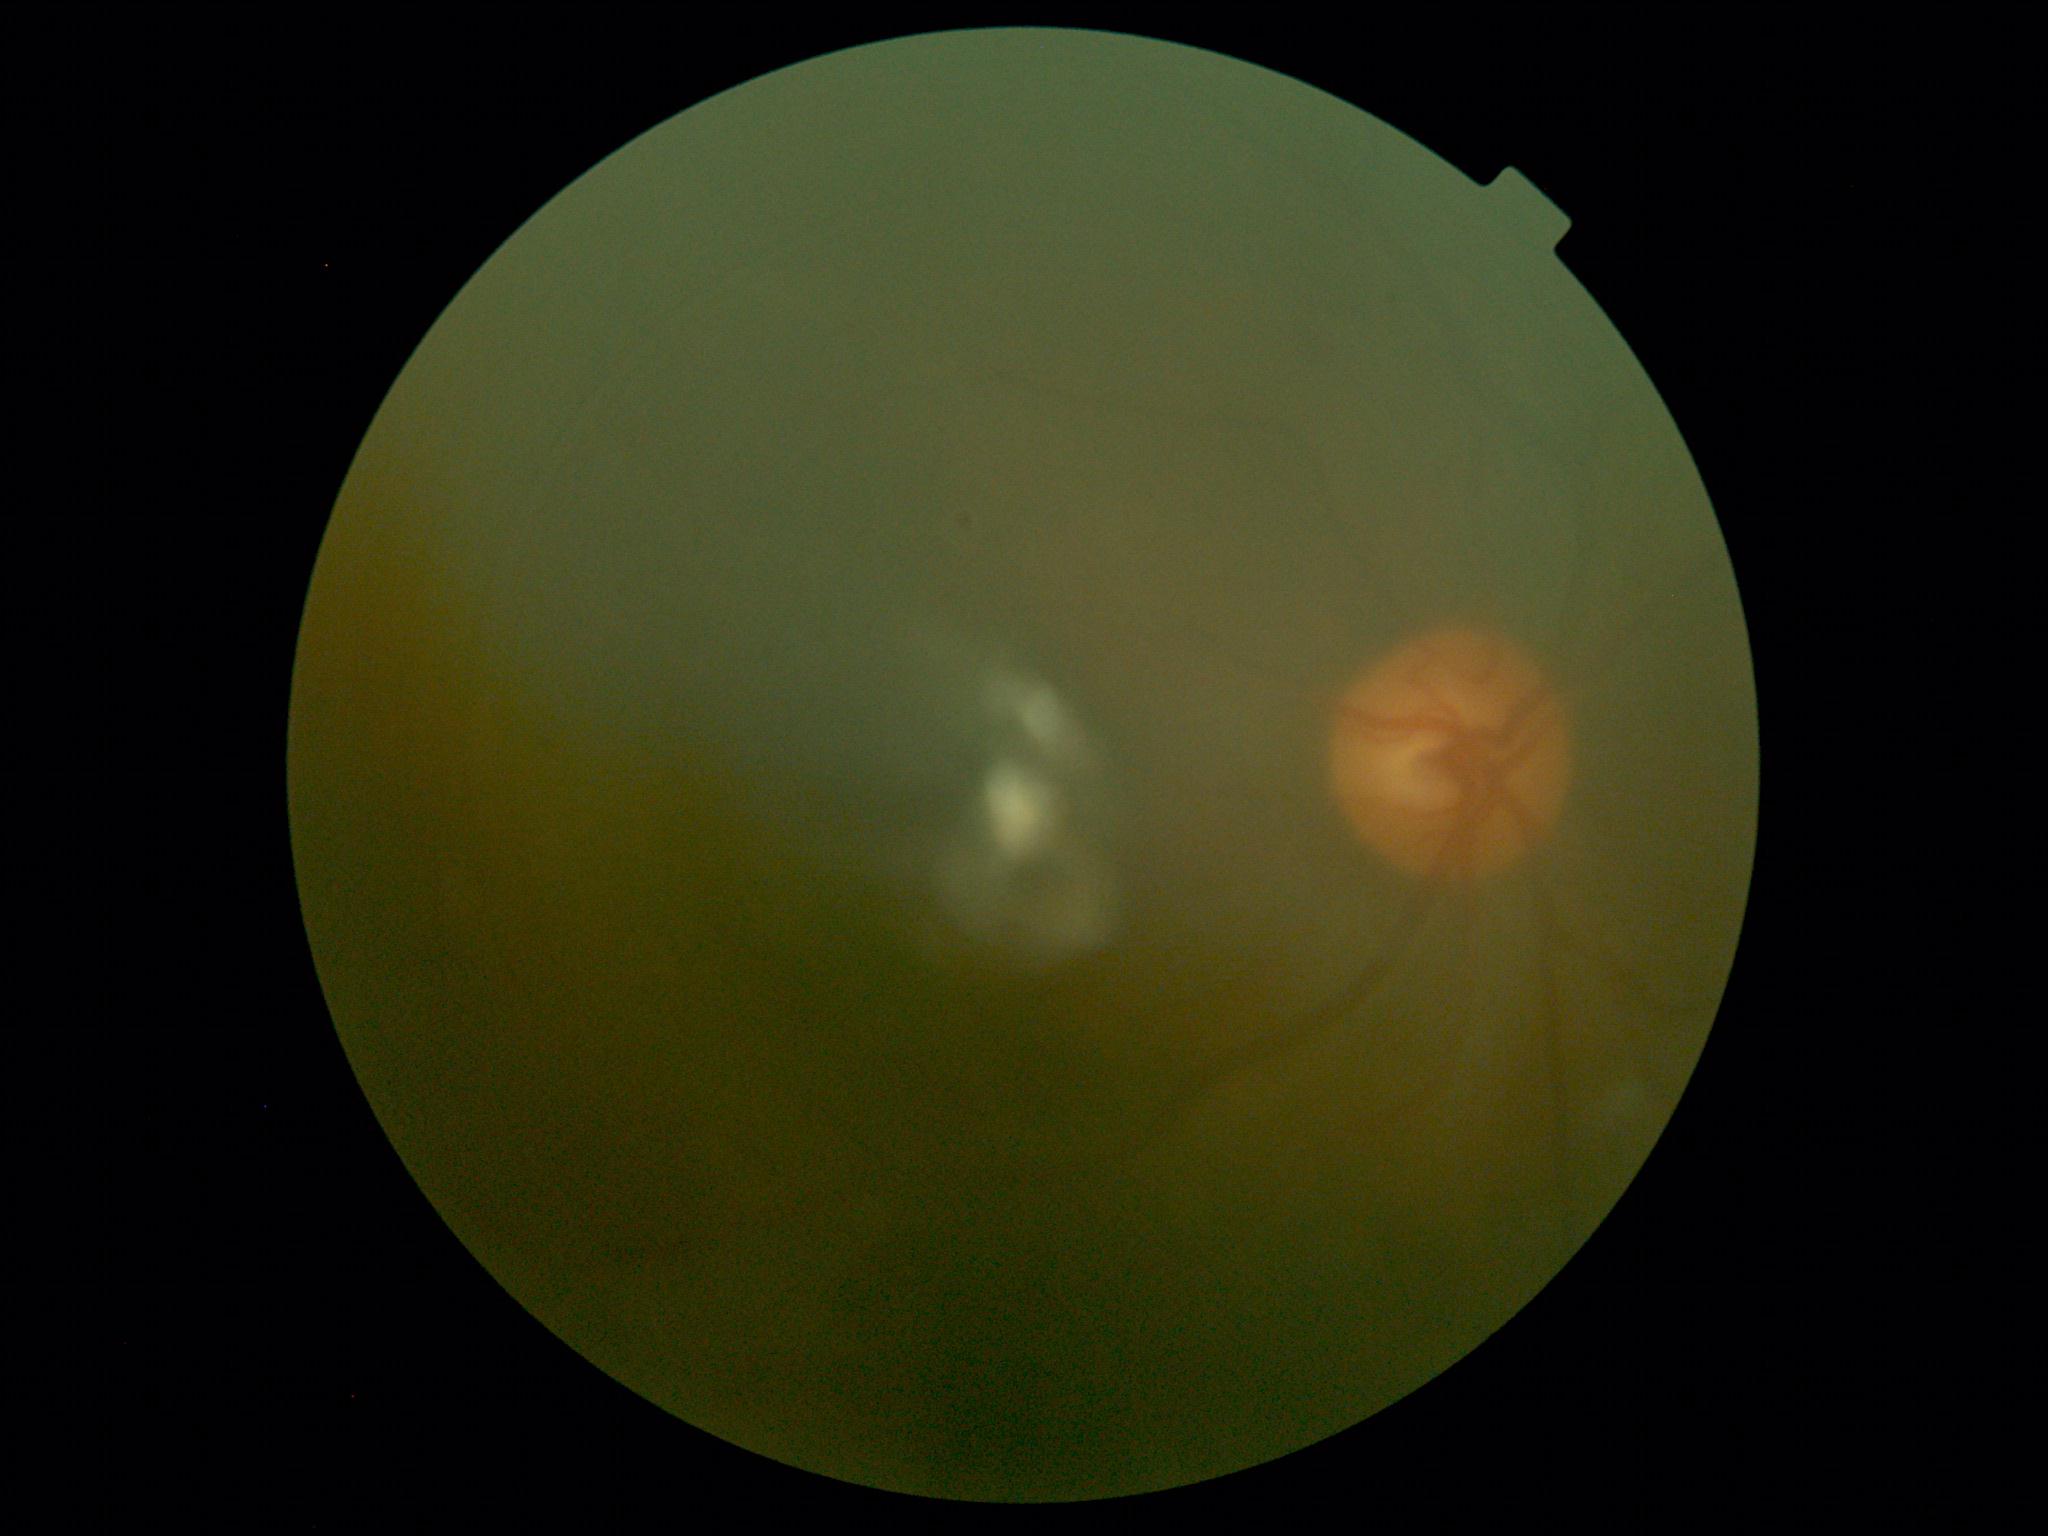

{
  "dr_grade": "ungradable"
}